ONH-centered crop from a color fundus image:
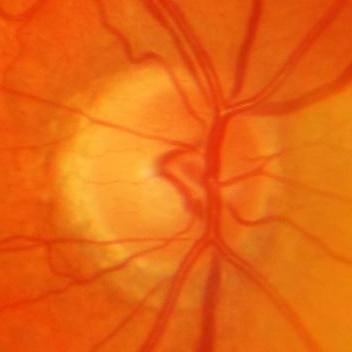 Q: Is glaucoma present?
A: Yes — glaucomatous findings.